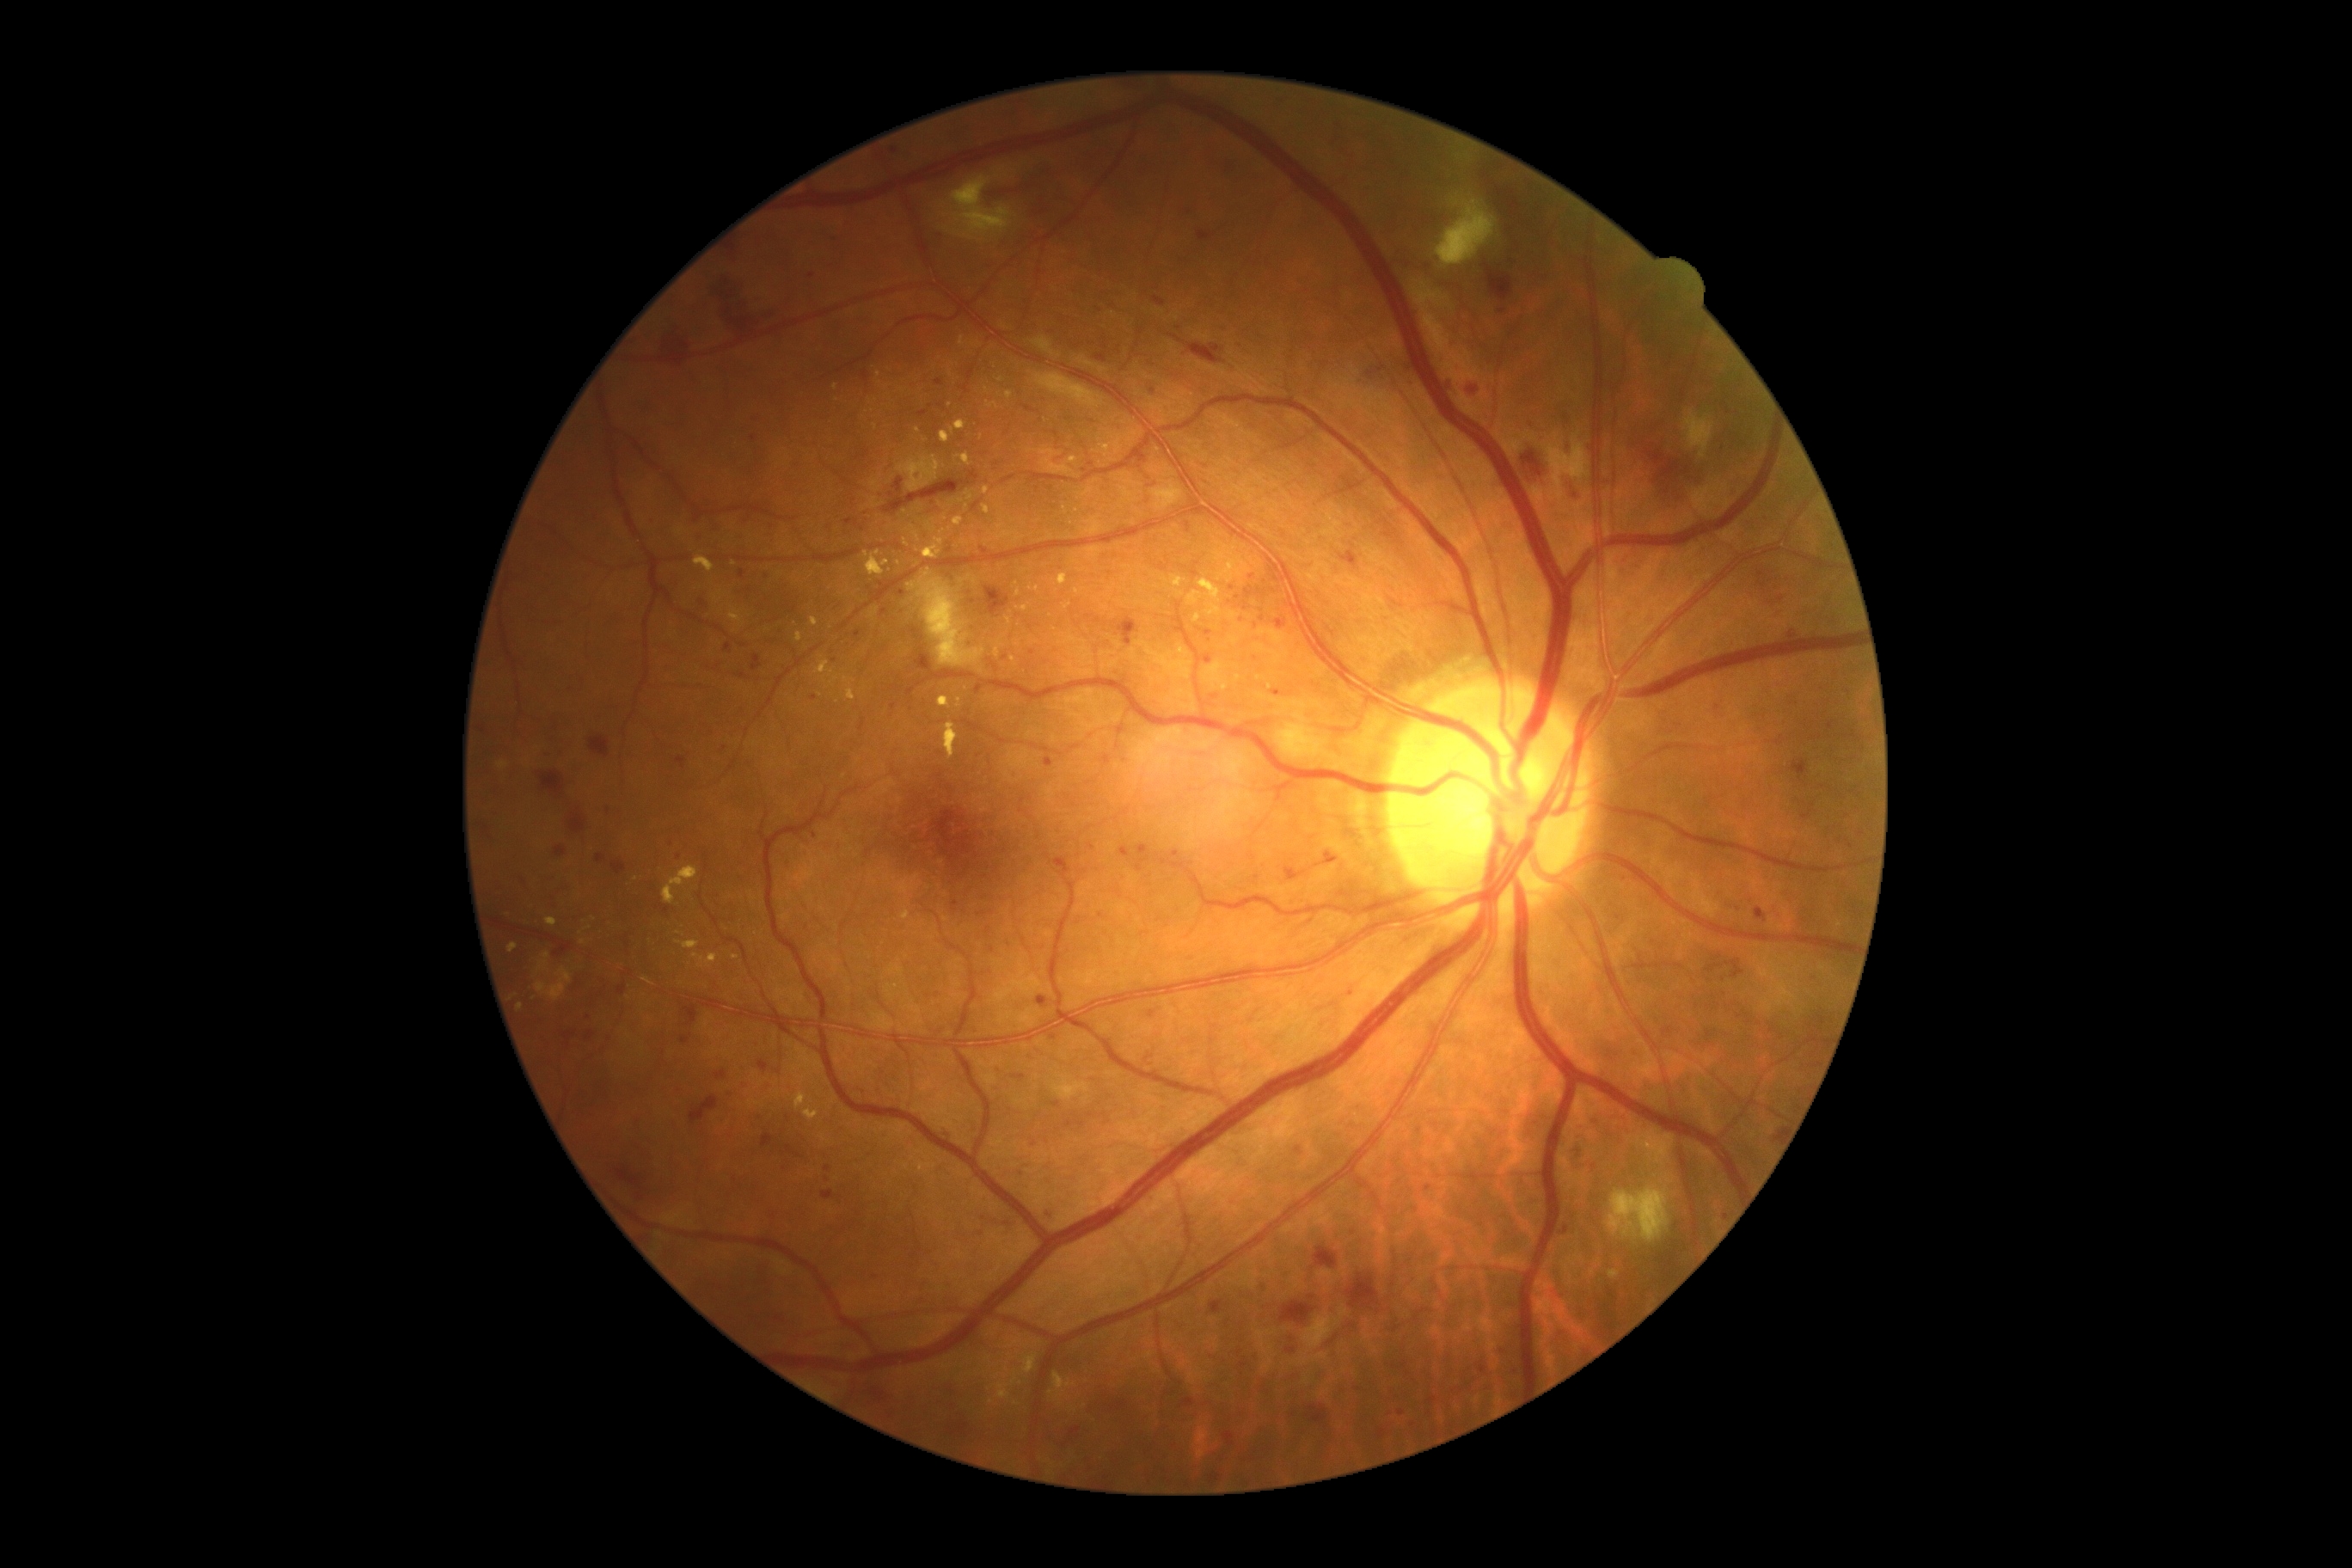
DR is grade 3; non-proliferative diabetic retinopathy
Selected lesions:
* MAs (continued): box=[1103, 756, 1112, 766] | box=[914, 474, 922, 482] | box=[725, 644, 732, 652] | box=[919, 412, 928, 419] | box=[1351, 988, 1356, 996] | box=[1122, 848, 1127, 859]
* Small MAs approximately at [x=679, y=857] | [x=1232, y=589] | [x=984, y=549] | [x=902, y=593] | [x=973, y=602] | [x=1409, y=369] | [x=954, y=900] | [x=1091, y=847] | [x=815, y=698] | [x=1451, y=384]
* HEs (continued): box=[821, 1191, 835, 1201] | box=[1280, 1302, 1314, 1325] | box=[713, 273, 776, 334] | box=[1155, 297, 1165, 307] | box=[591, 737, 609, 757] | box=[761, 1136, 775, 1148] | box=[1182, 1399, 1194, 1407] | box=[1464, 379, 1478, 398] | box=[1347, 1275, 1378, 1309] | box=[916, 654, 933, 671] | box=[1572, 1141, 1579, 1165] | box=[1445, 379, 1450, 395] | box=[1096, 355, 1106, 362] | box=[539, 771, 565, 795] | box=[1287, 1349, 1295, 1354] | box=[1038, 996, 1048, 1008] | box=[683, 1005, 699, 1027]
* EXs (continued): box=[1053, 1373, 1075, 1395] | box=[1010, 656, 1017, 666] | box=[706, 953, 718, 967] | box=[1024, 1356, 1038, 1375] | box=[938, 697, 952, 707] | box=[914, 532, 921, 541] | box=[1170, 575, 1185, 589] | box=[536, 969, 572, 1001] | box=[694, 953, 704, 964] | box=[995, 647, 1001, 659] | box=[1063, 604, 1072, 611]
* Small EXs approximately at [x=1239, y=680] | [x=1077, y=591] | [x=582, y=943] | [x=594, y=919] | [x=1018, y=645] | [x=1001, y=380] | [x=997, y=1377] | [x=991, y=1403]